CFP, non-mydriatic acquisition:
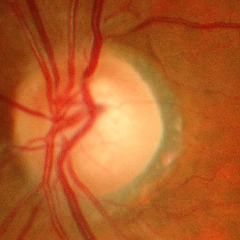 Optic disc appearance consistent with advanced glaucoma.